Fundus photo — 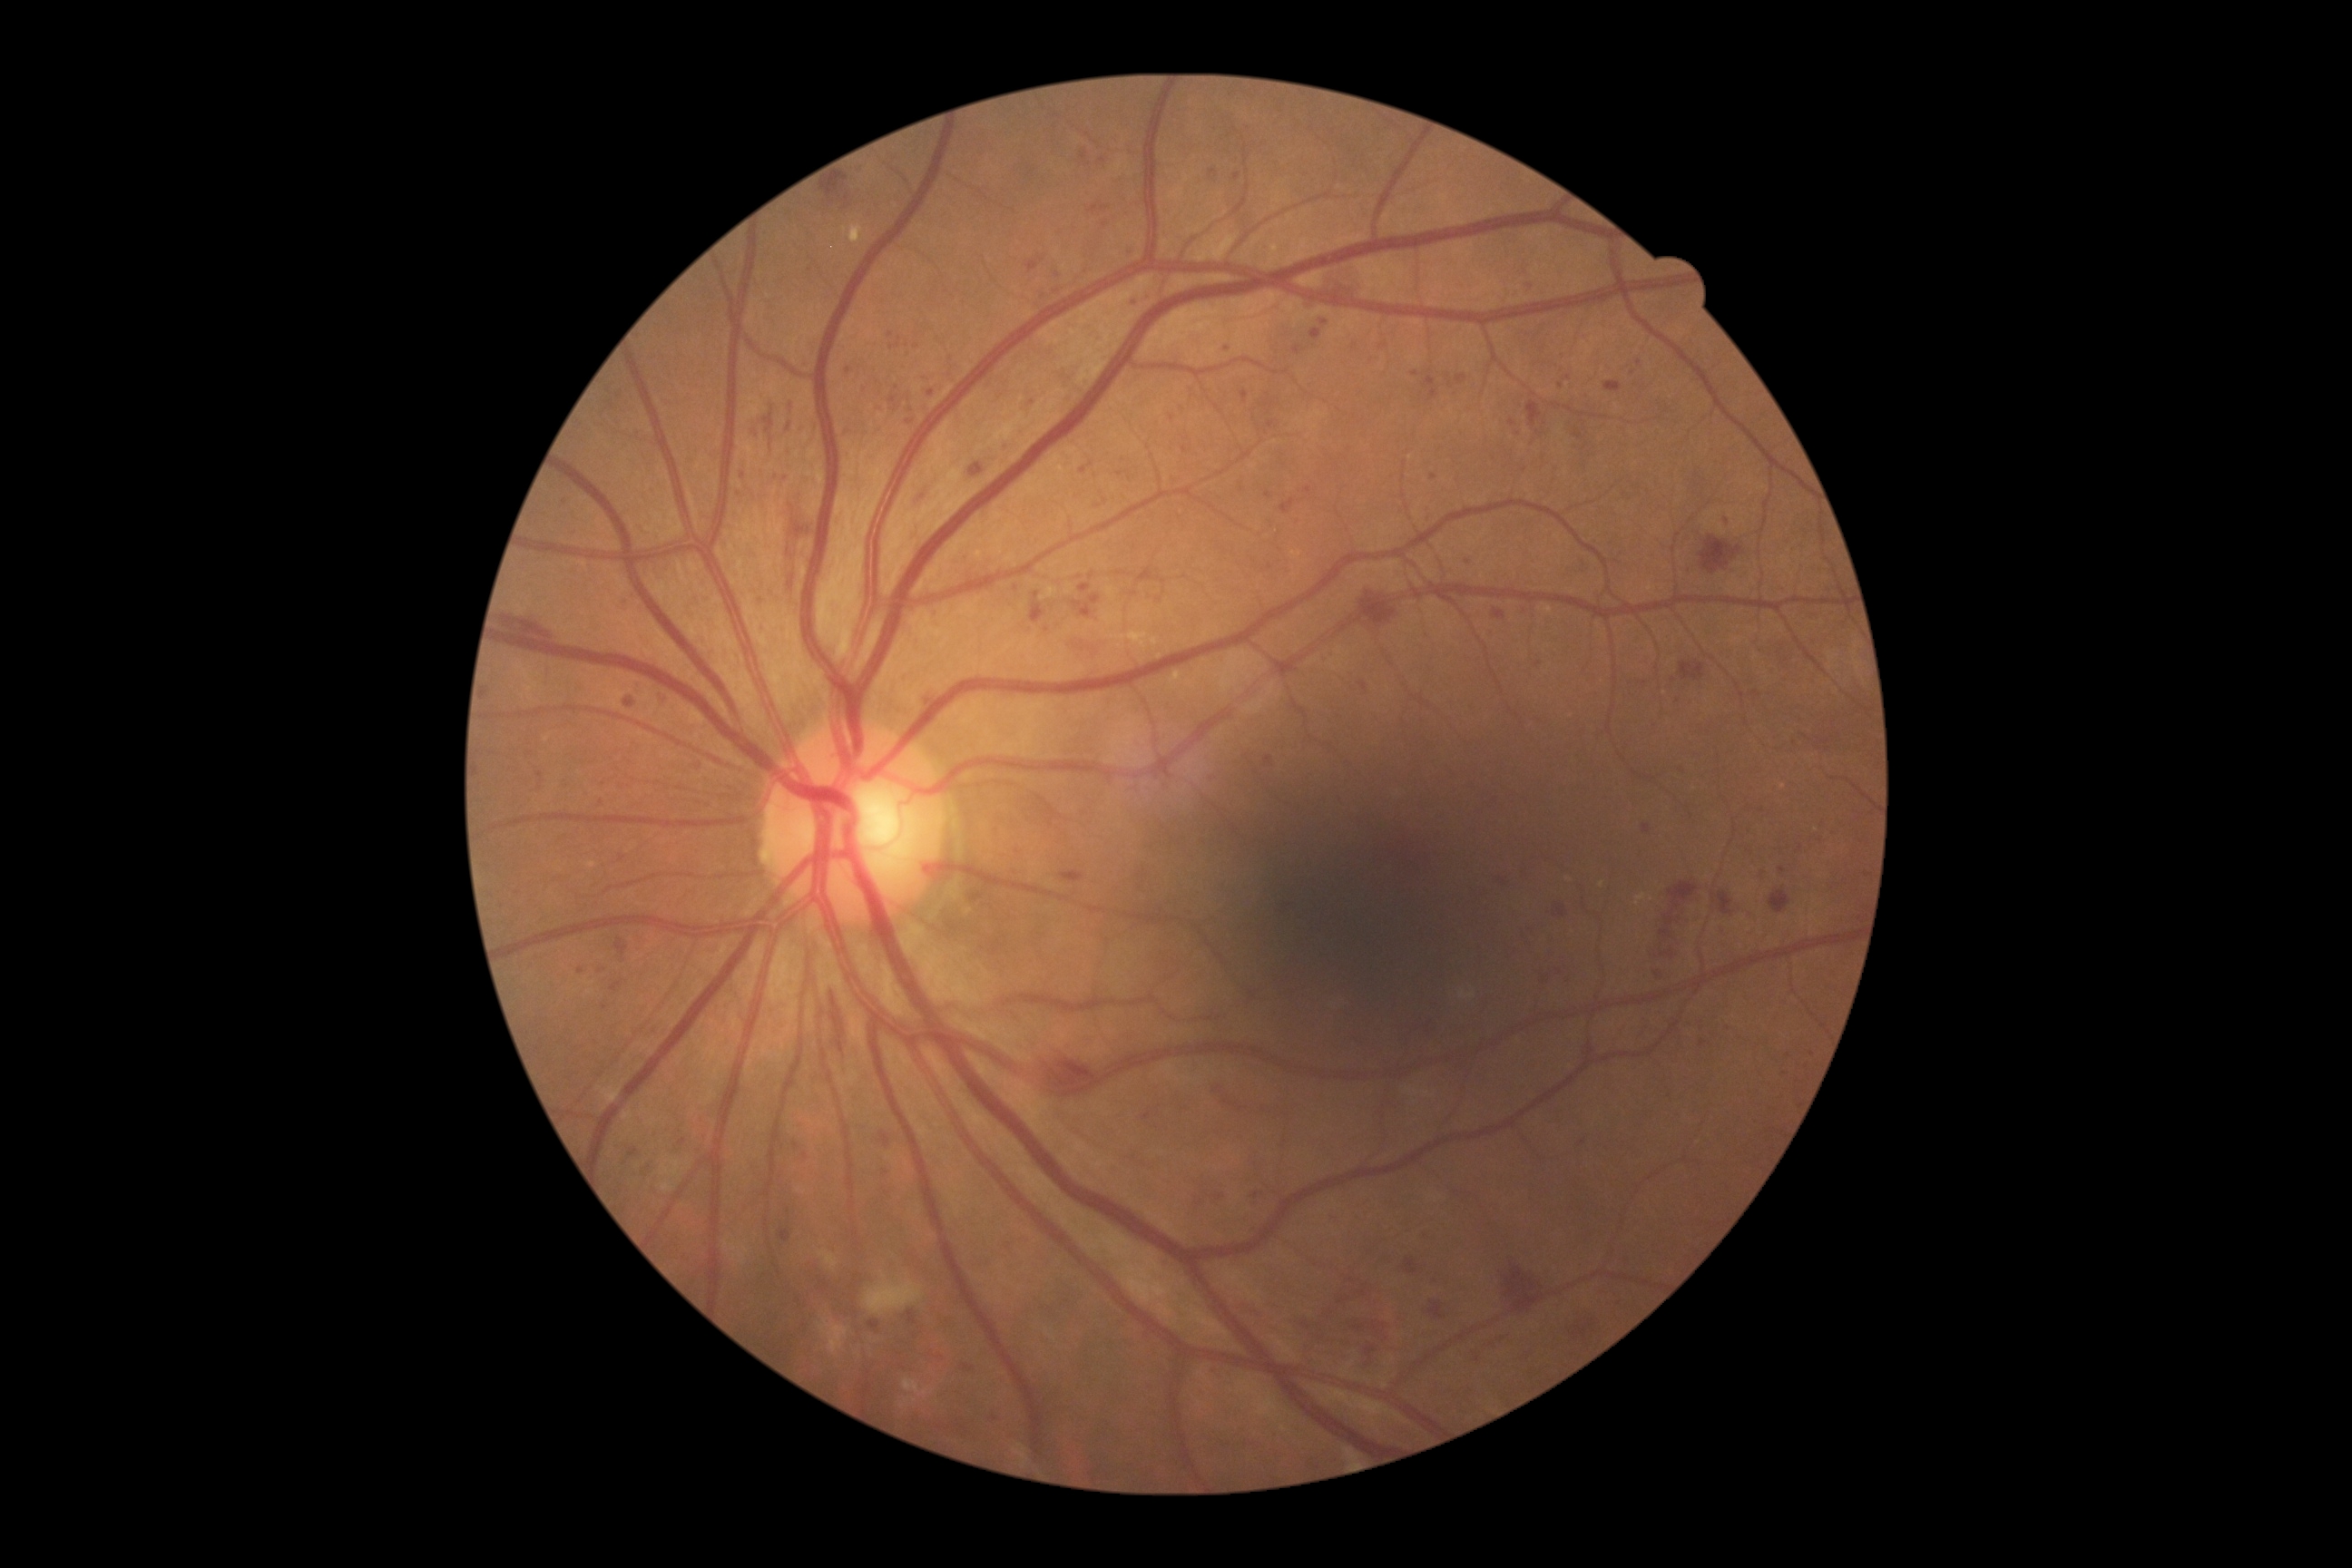

DR grade is severe non-proliferative diabetic retinopathy (3); non-proliferative diabetic retinopathy
Selected lesions:
MAs (continued): 770 402 776 411; 963 1364 974 1371; 1355 1328 1364 1331; 1026 262 1039 273; 1311 329 1320 340; 923 692 936 707; 1215 1195 1224 1202; 1366 1346 1377 1357
Small MAs approximately at 487, 693; 1415, 374; 1478, 1360; 772, 440; 1120, 473; 1269, 404; 1560, 972; 1083, 472; 789, 427; 634, 1153